Graded on the modified Davis scale — 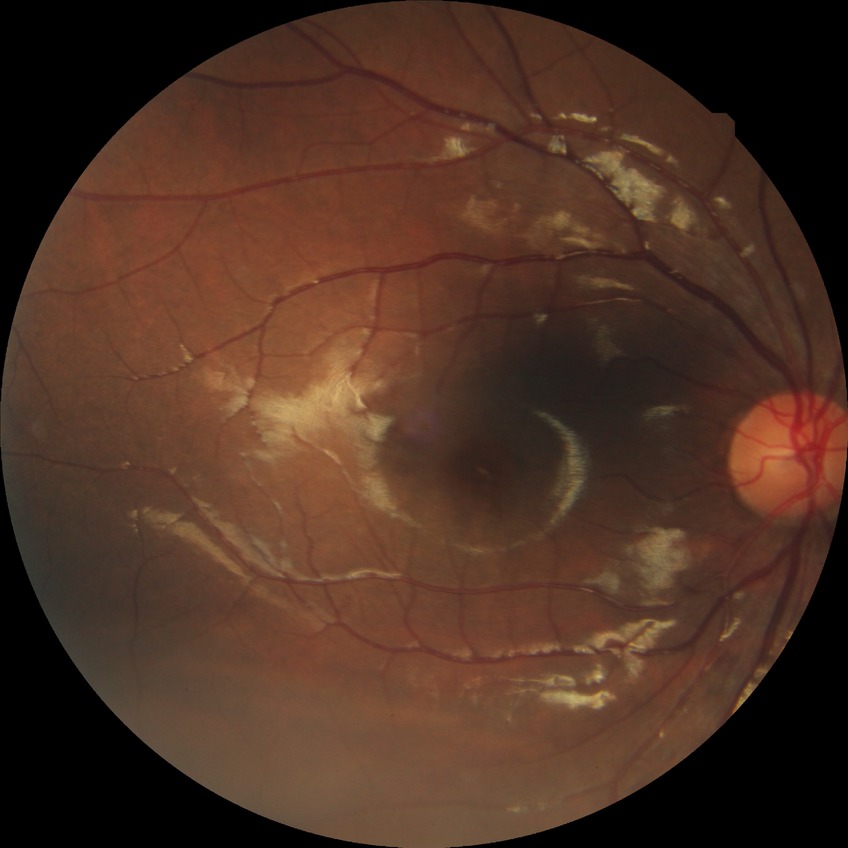

diabetic retinopathy grade = no diabetic retinopathy